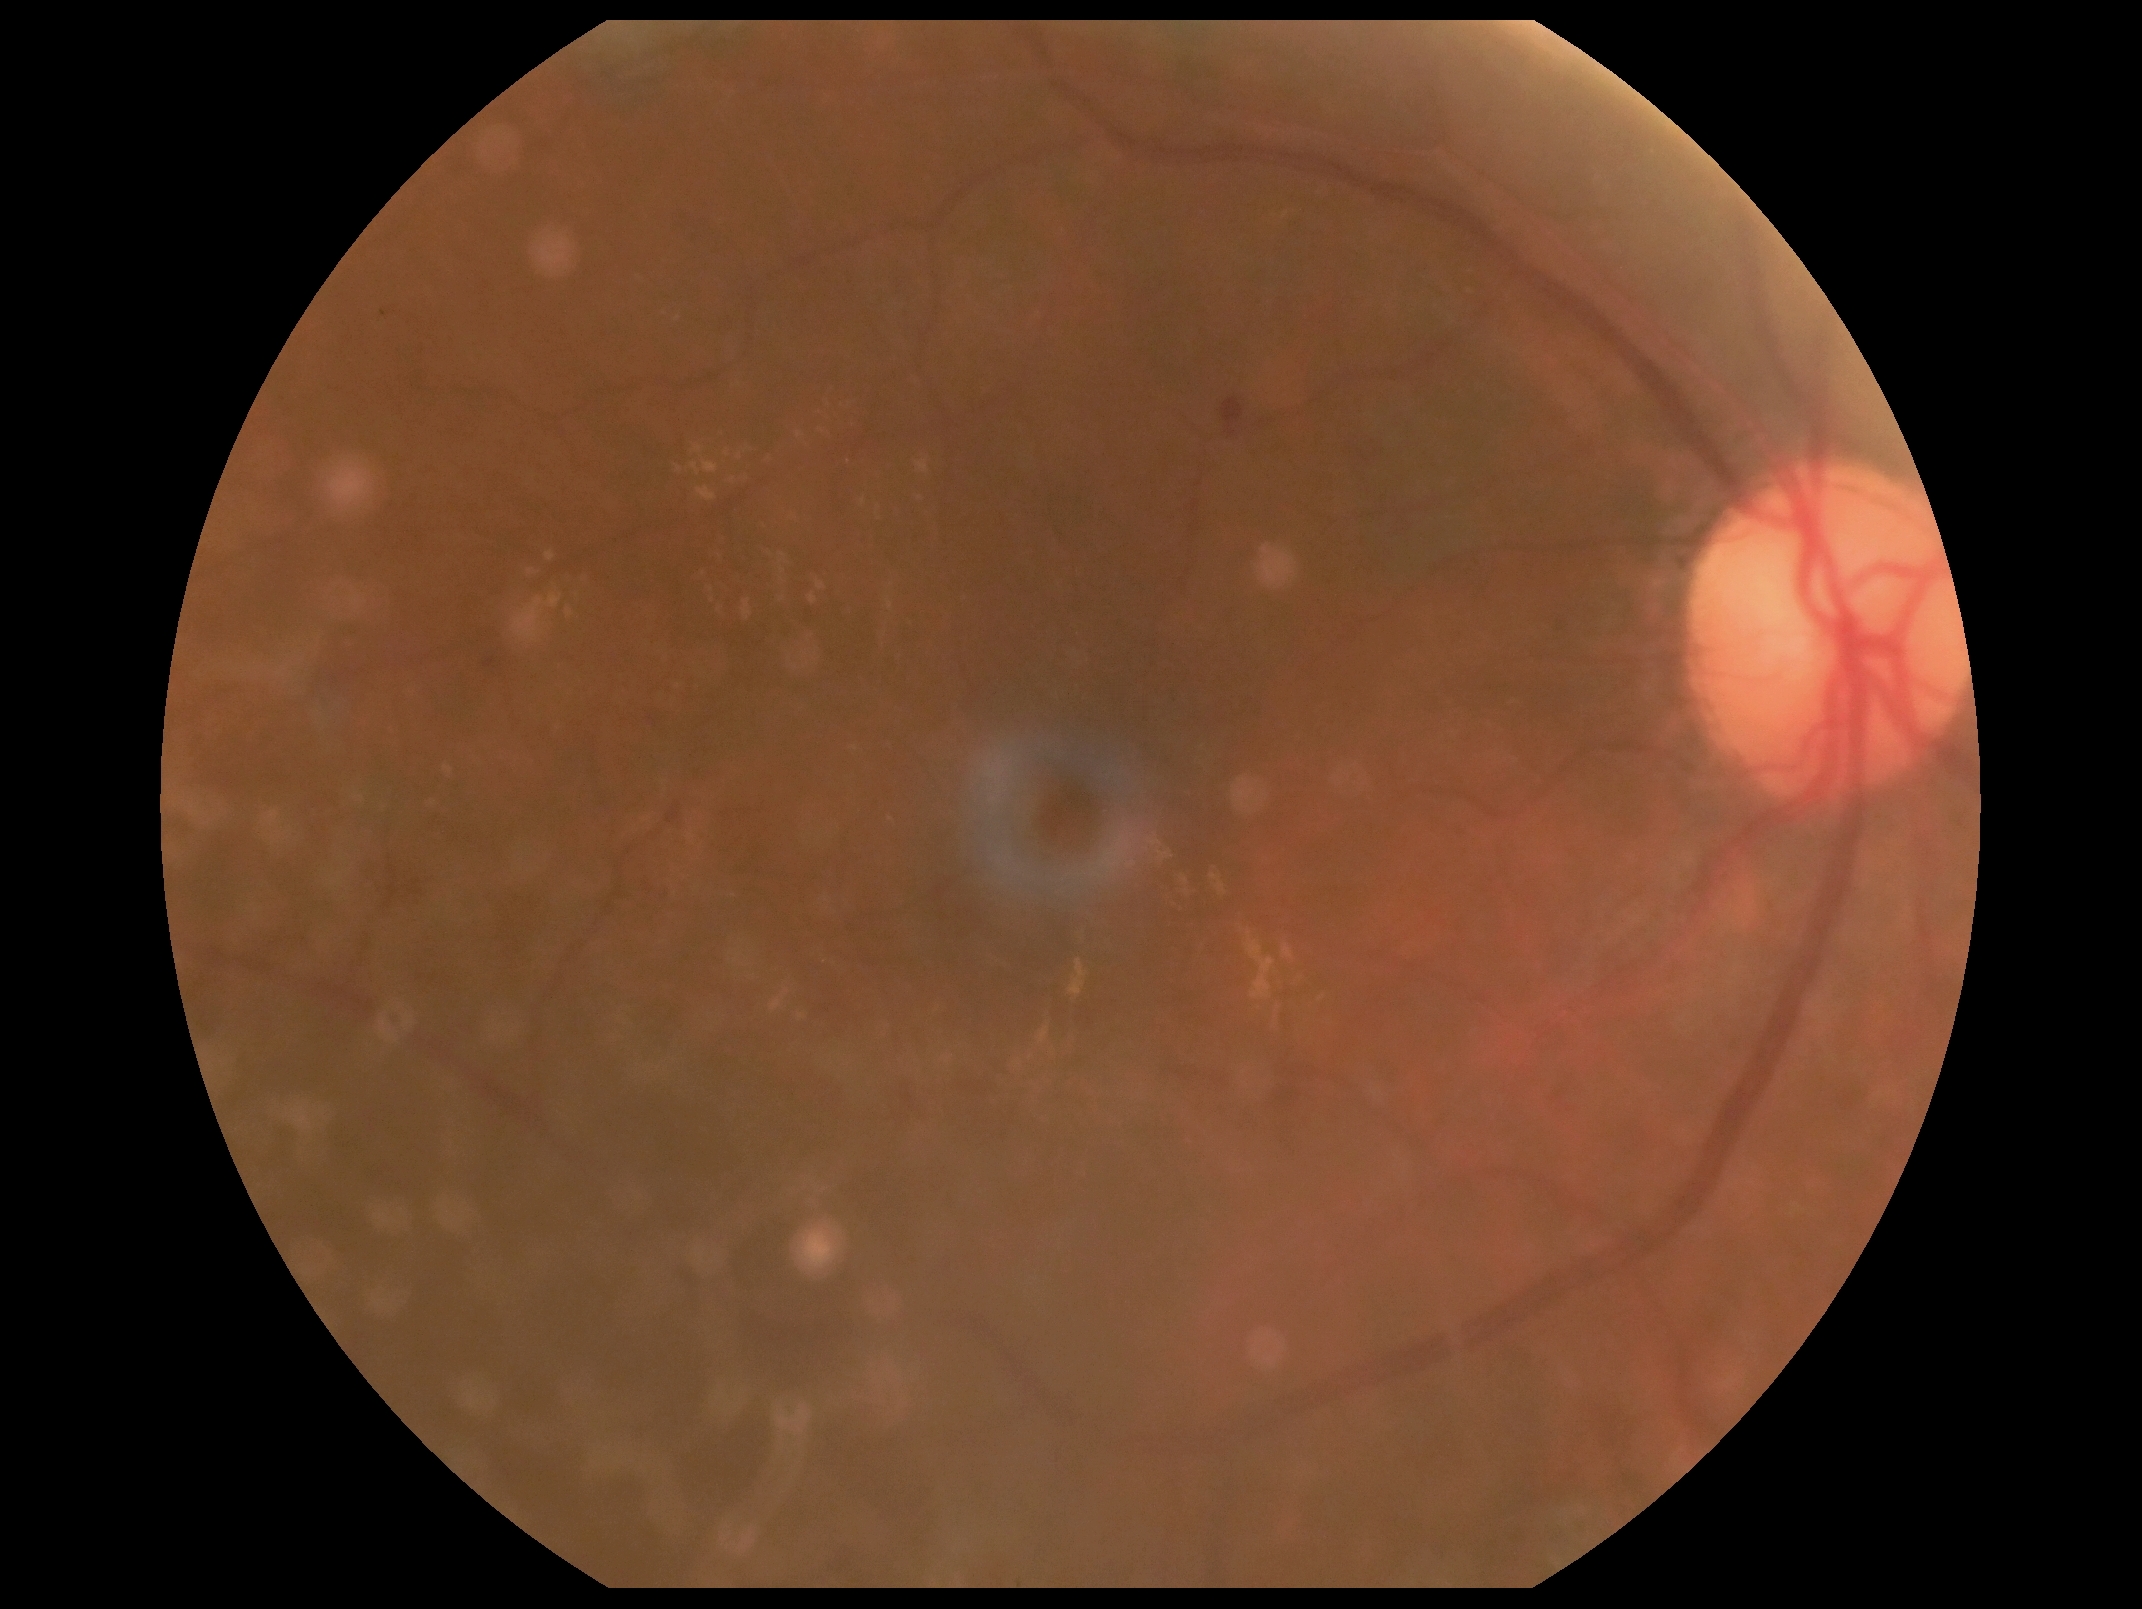
{"dr_category": "non-proliferative diabetic retinopathy", "dr_grade": "2"}